Color fundus image · captured on a Remidio FOP fundus camera: 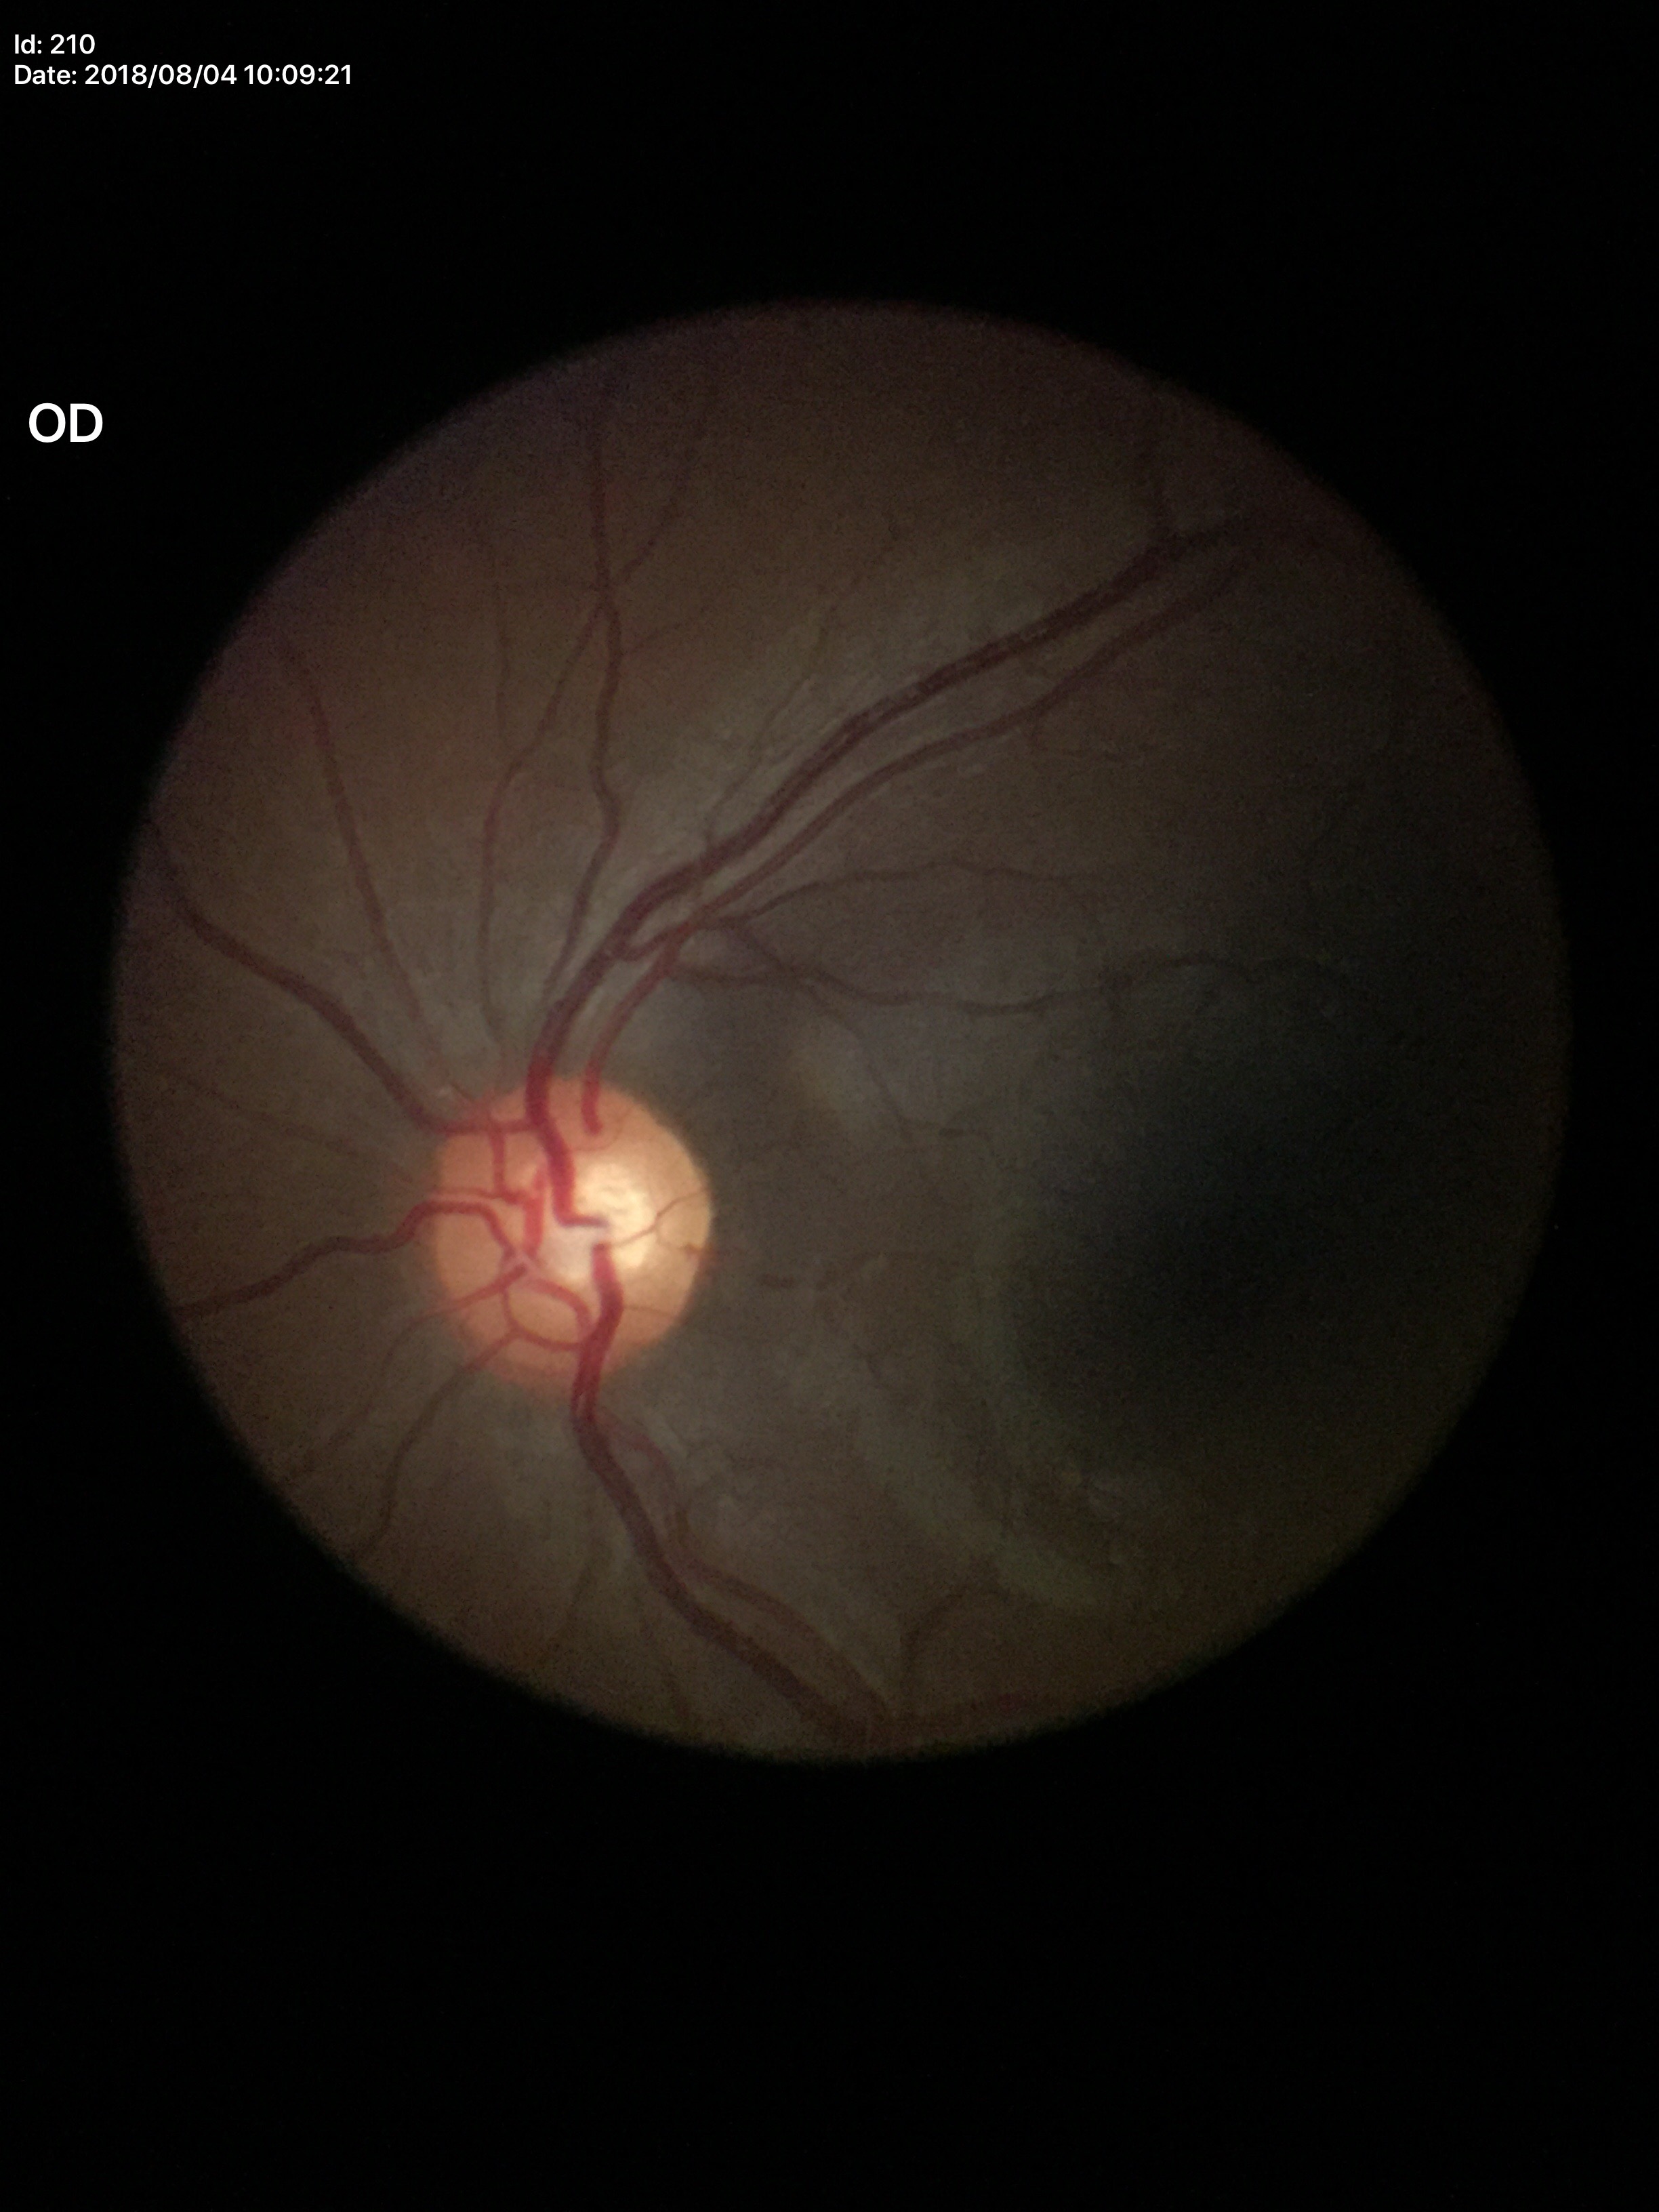
{"glaucoma_decision": "negative (2 of 5 graders flagged glaucoma suspect)", "vcdr": "0.57", "hcdr": "0.58"}